CFP, modified Davis classification: 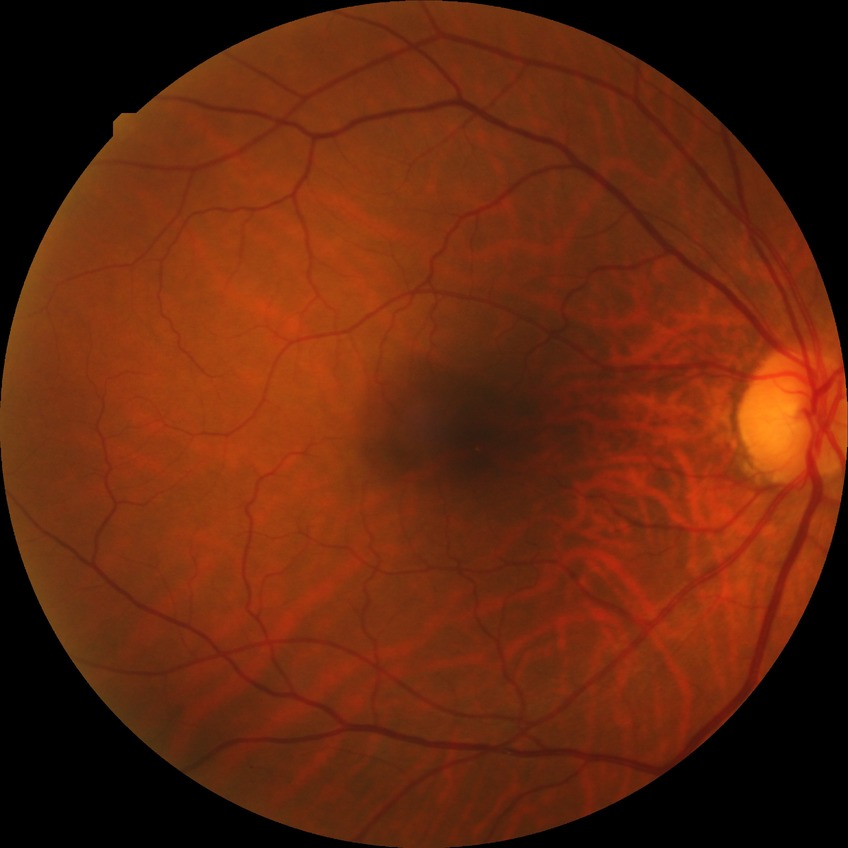
Diabetic retinopathy stage: no diabetic retinopathy.